Fundus photo
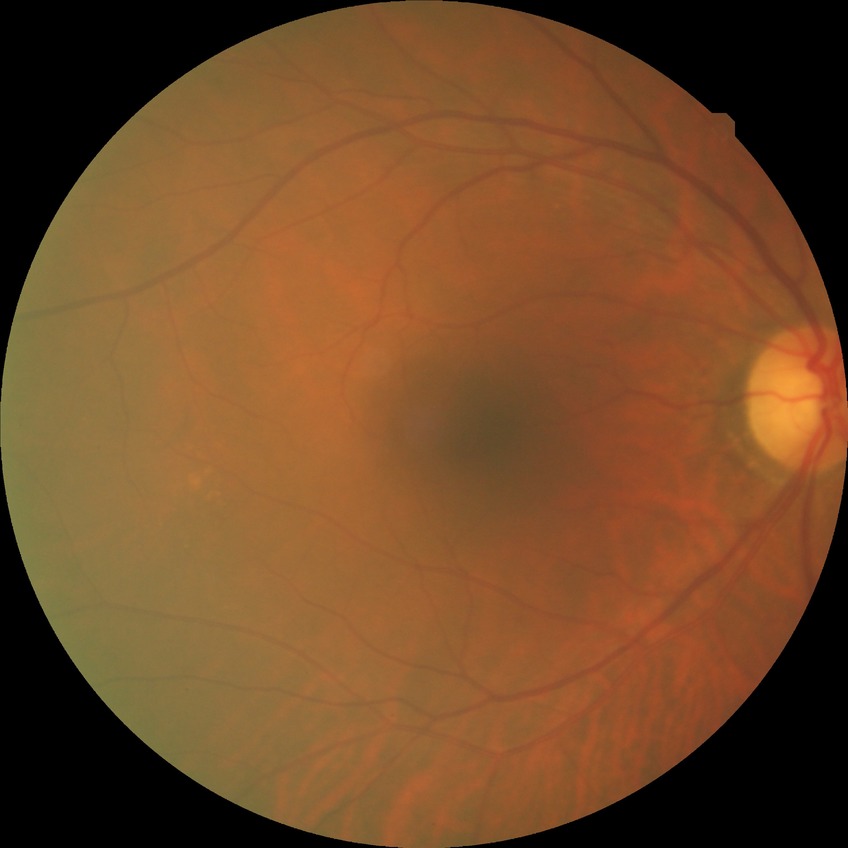

No signs of diabetic retinopathy. DR grade: NDR.